Retinal fundus photograph, 45-degree field of view.
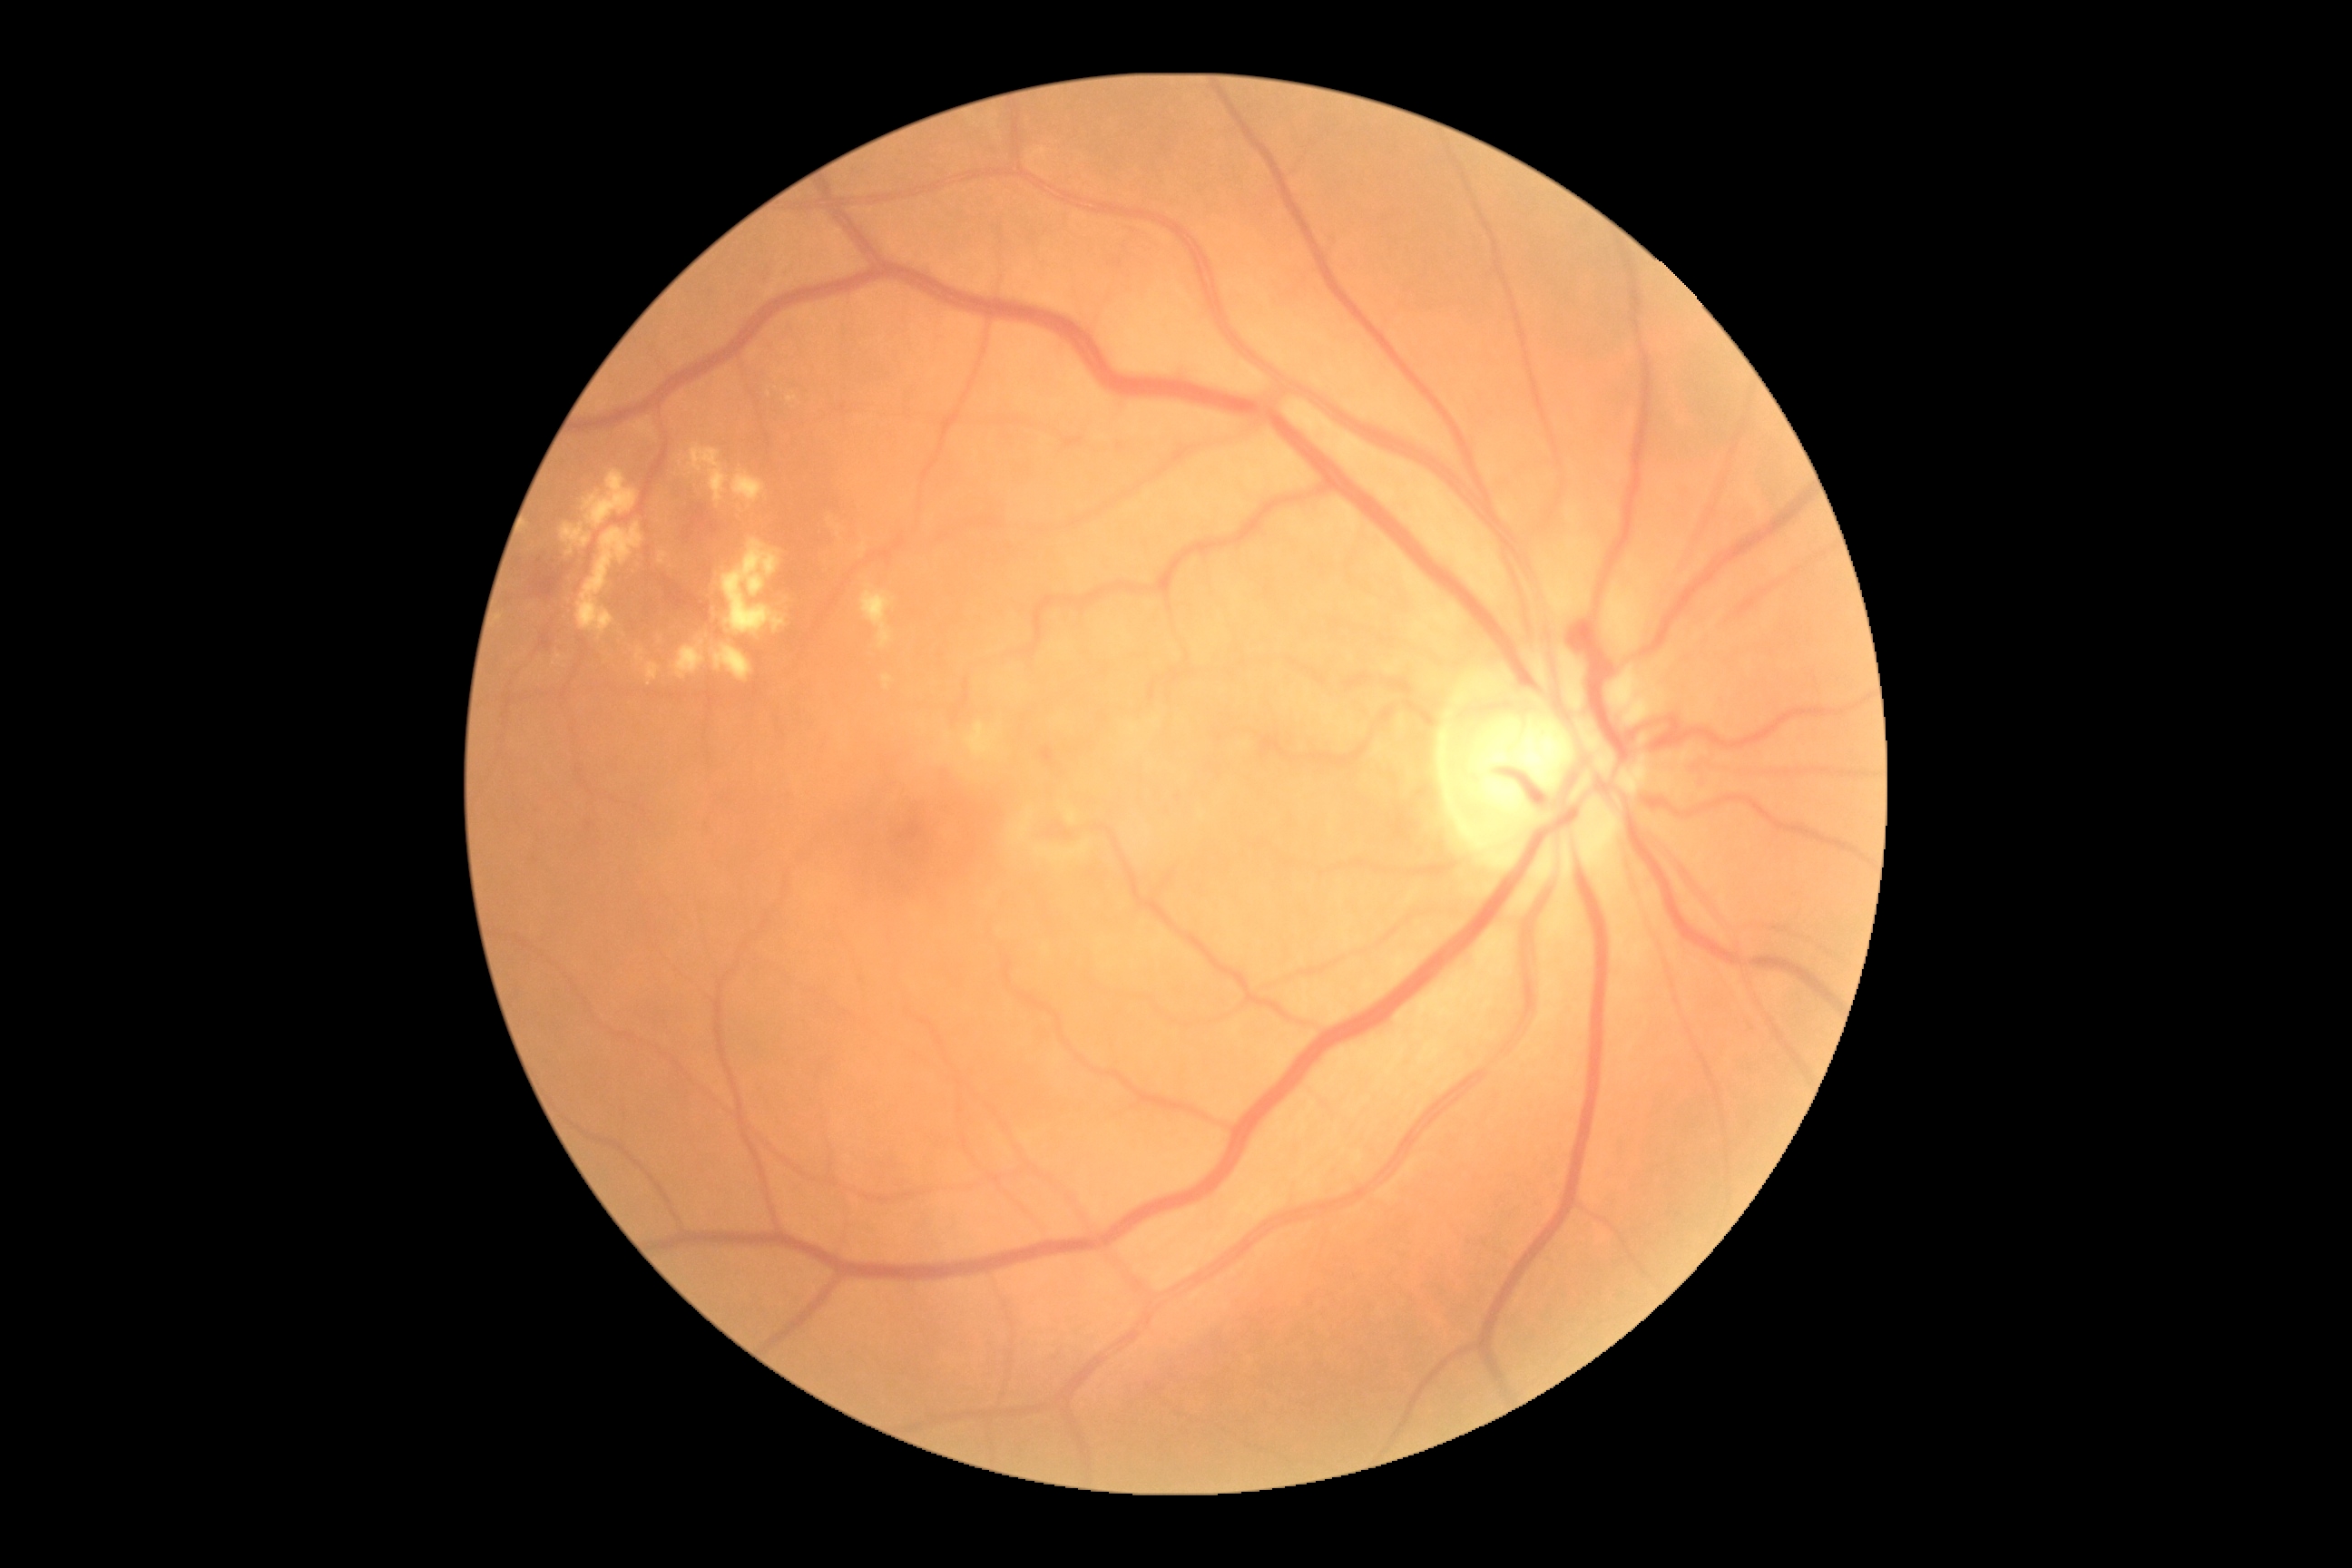

Diabetic retinopathy (DR): moderate NPDR (grade 2).